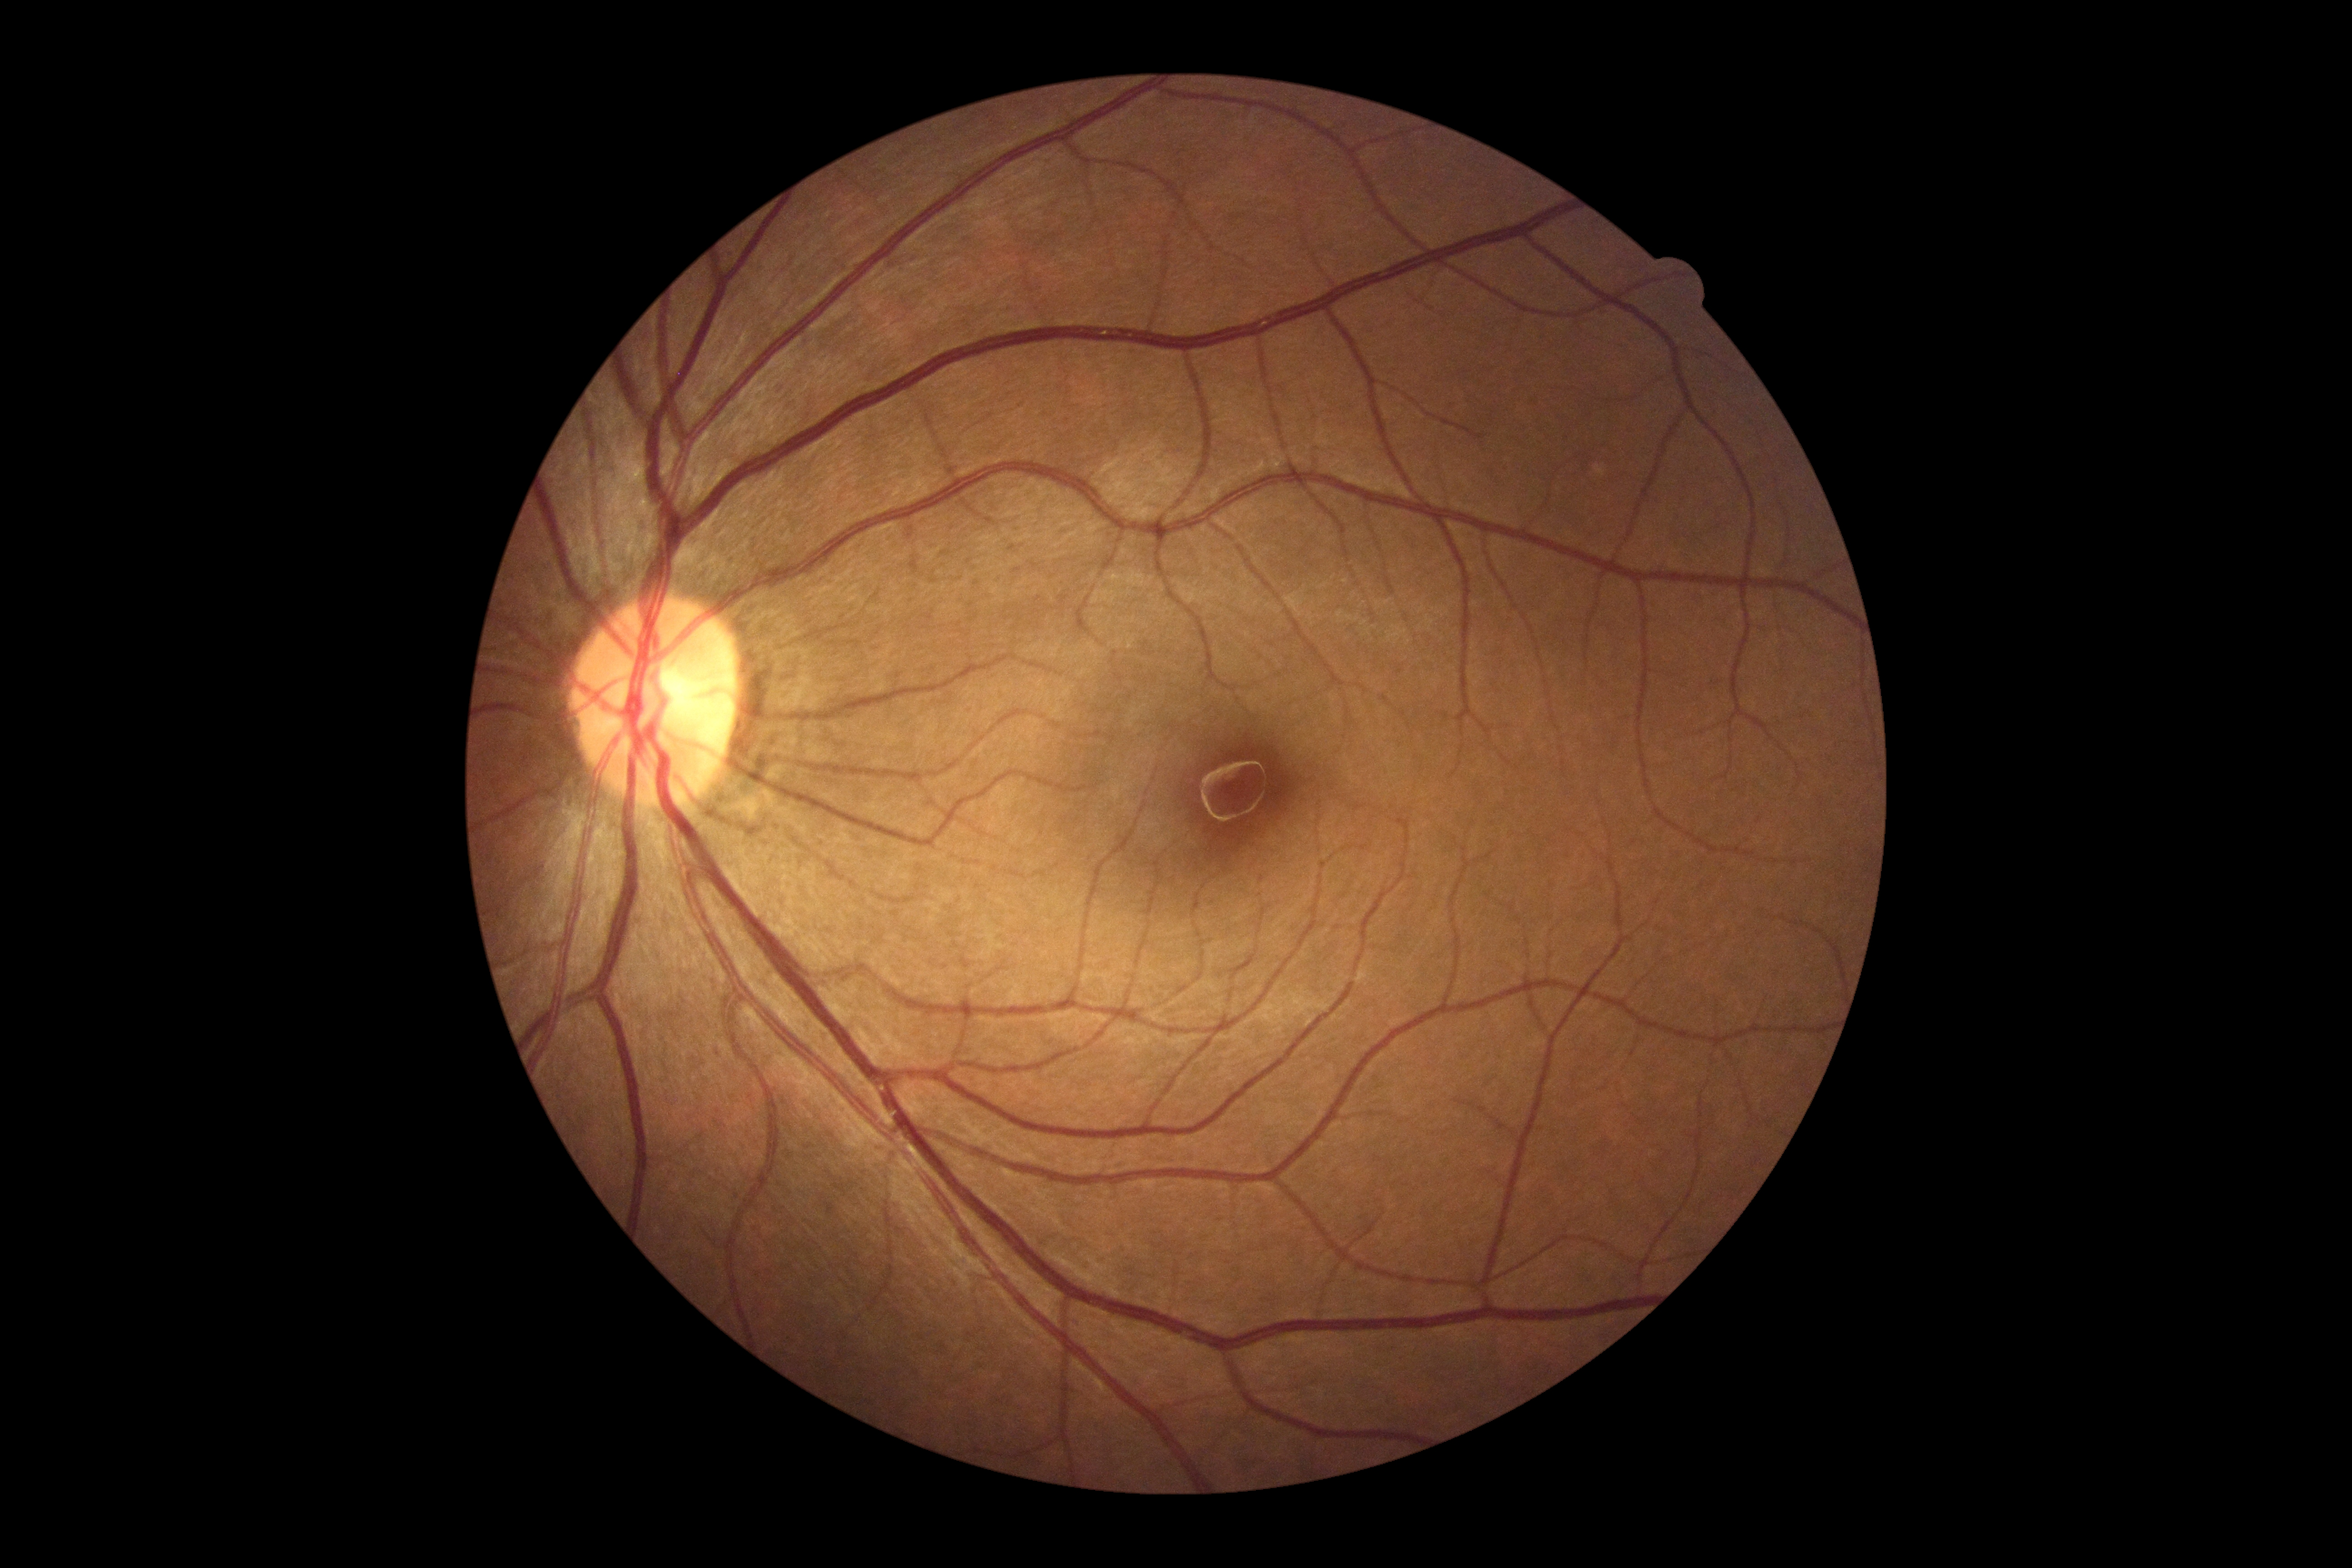
DR severity is grade 0.